CFP:
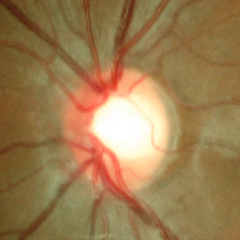
Glaucoma assessment: early glaucoma.